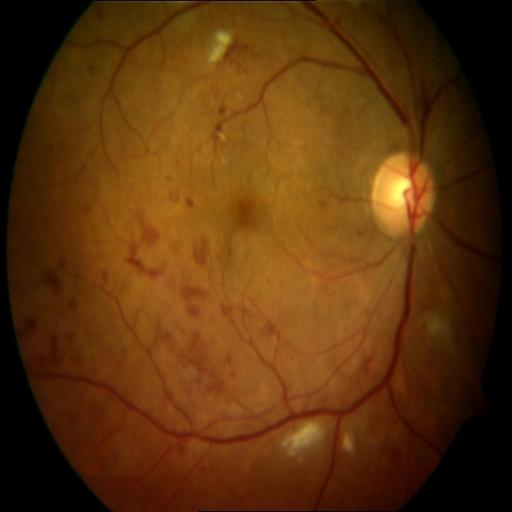

Fundus image with findings of hemorrhagic retinopathy (HR) and cotton wool spots (CWS).